NIDEK AFC-230 fundus camera.
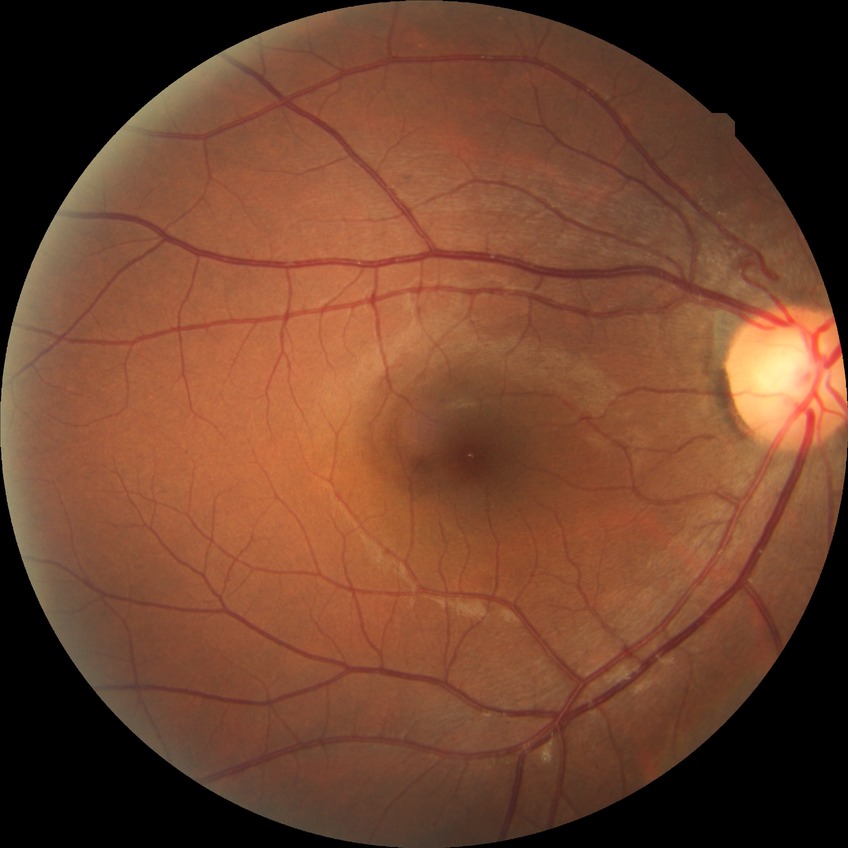

diabetic retinopathy grade=no diabetic retinopathy.